45° field of view · 848x848px — 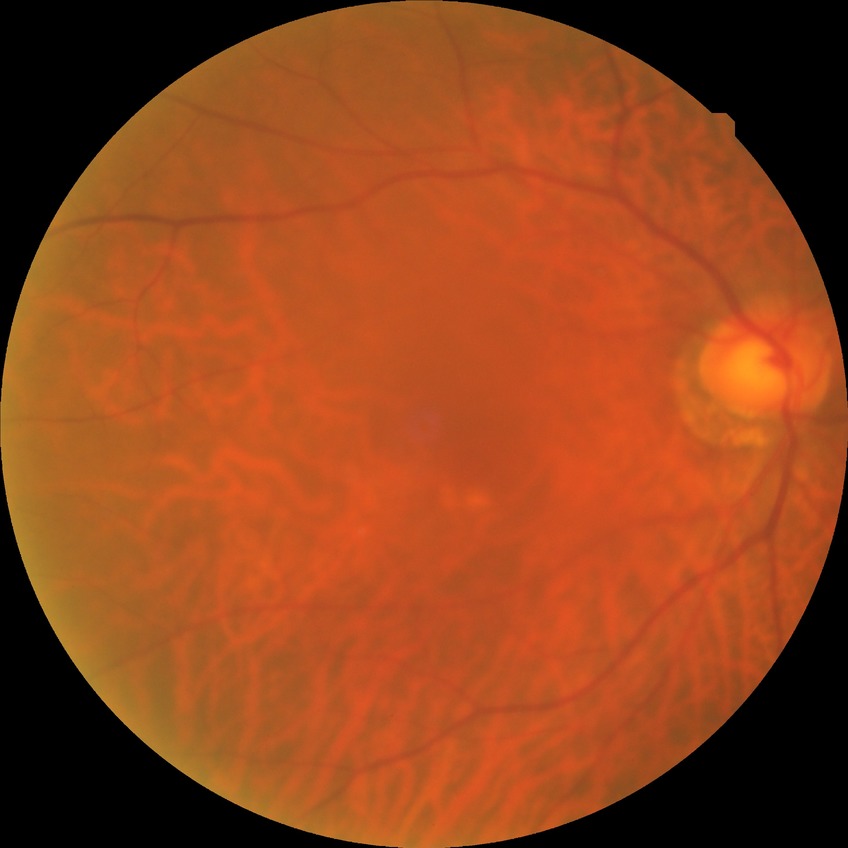

– diabetic retinopathy grade: no diabetic retinopathy